30° field of view; captured on a Topcon TRC-NW400 fundus camera.
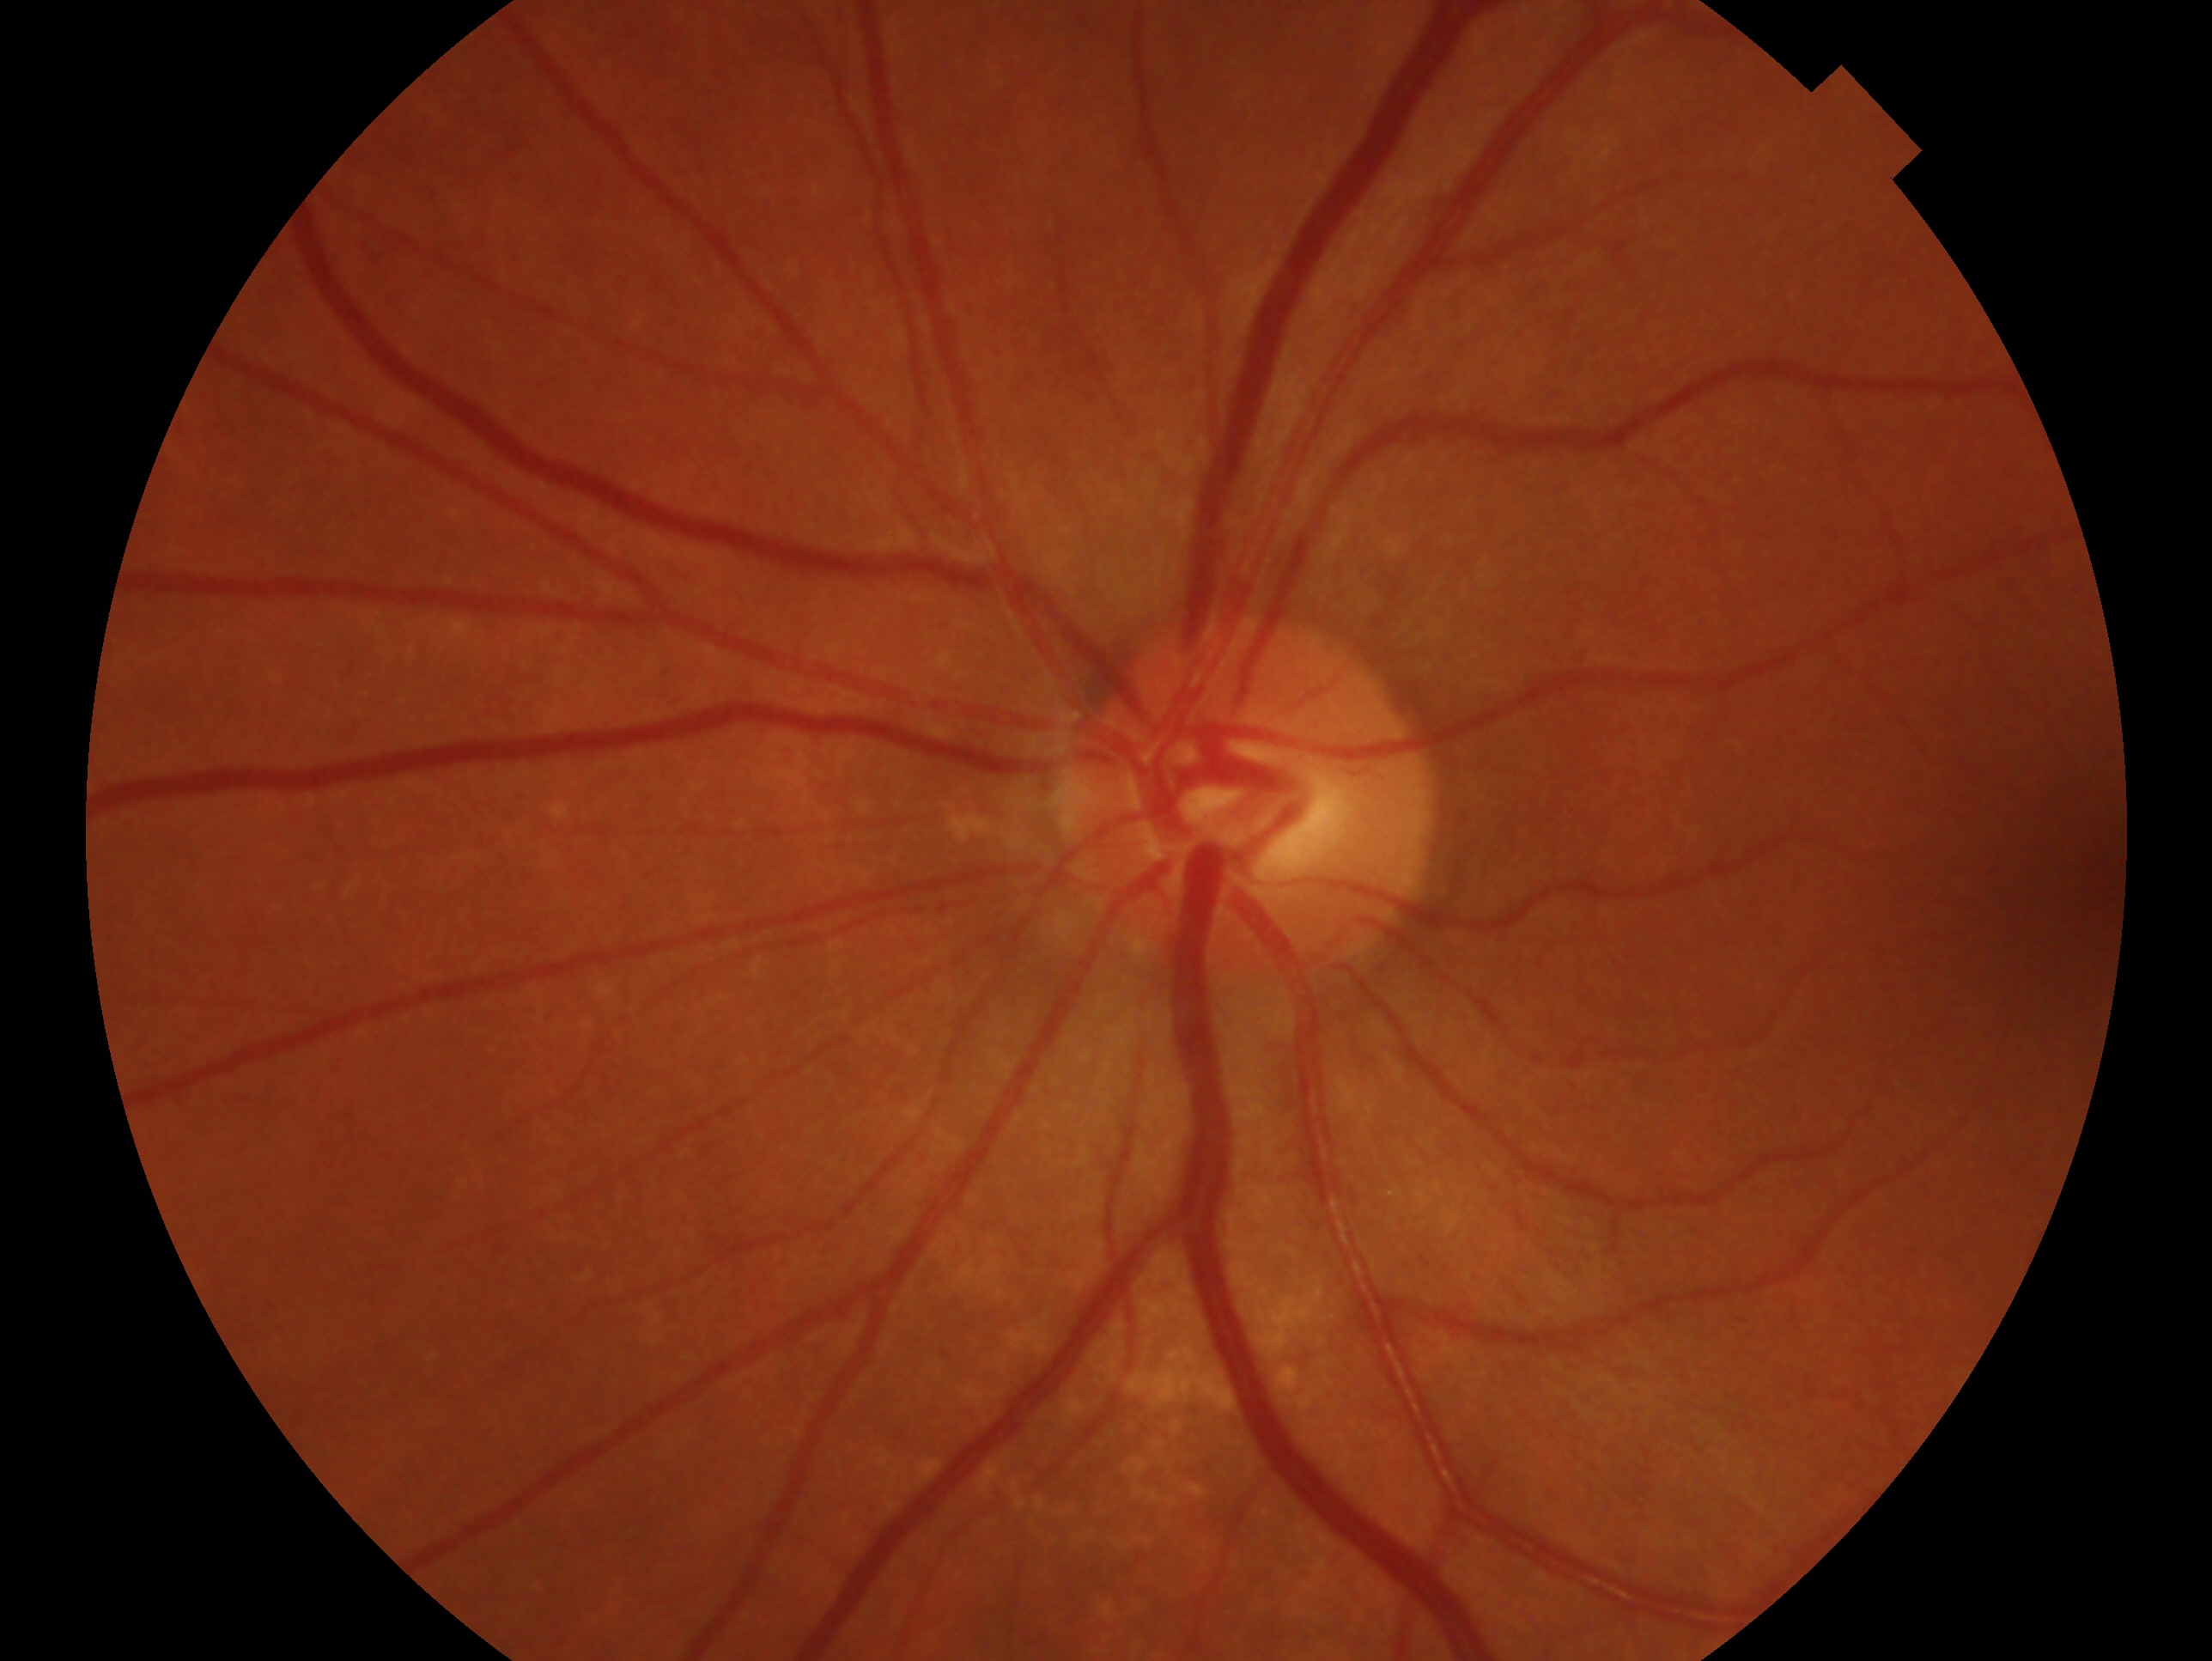 glaucoma diagnosis = no glaucoma — no clinical evidence of glaucoma in this eye | eye = OS.